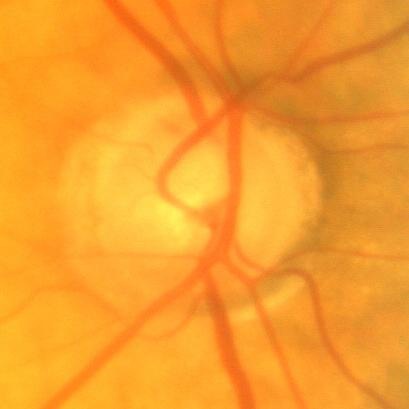 Glaucoma diagnosis: no signs of glaucoma.